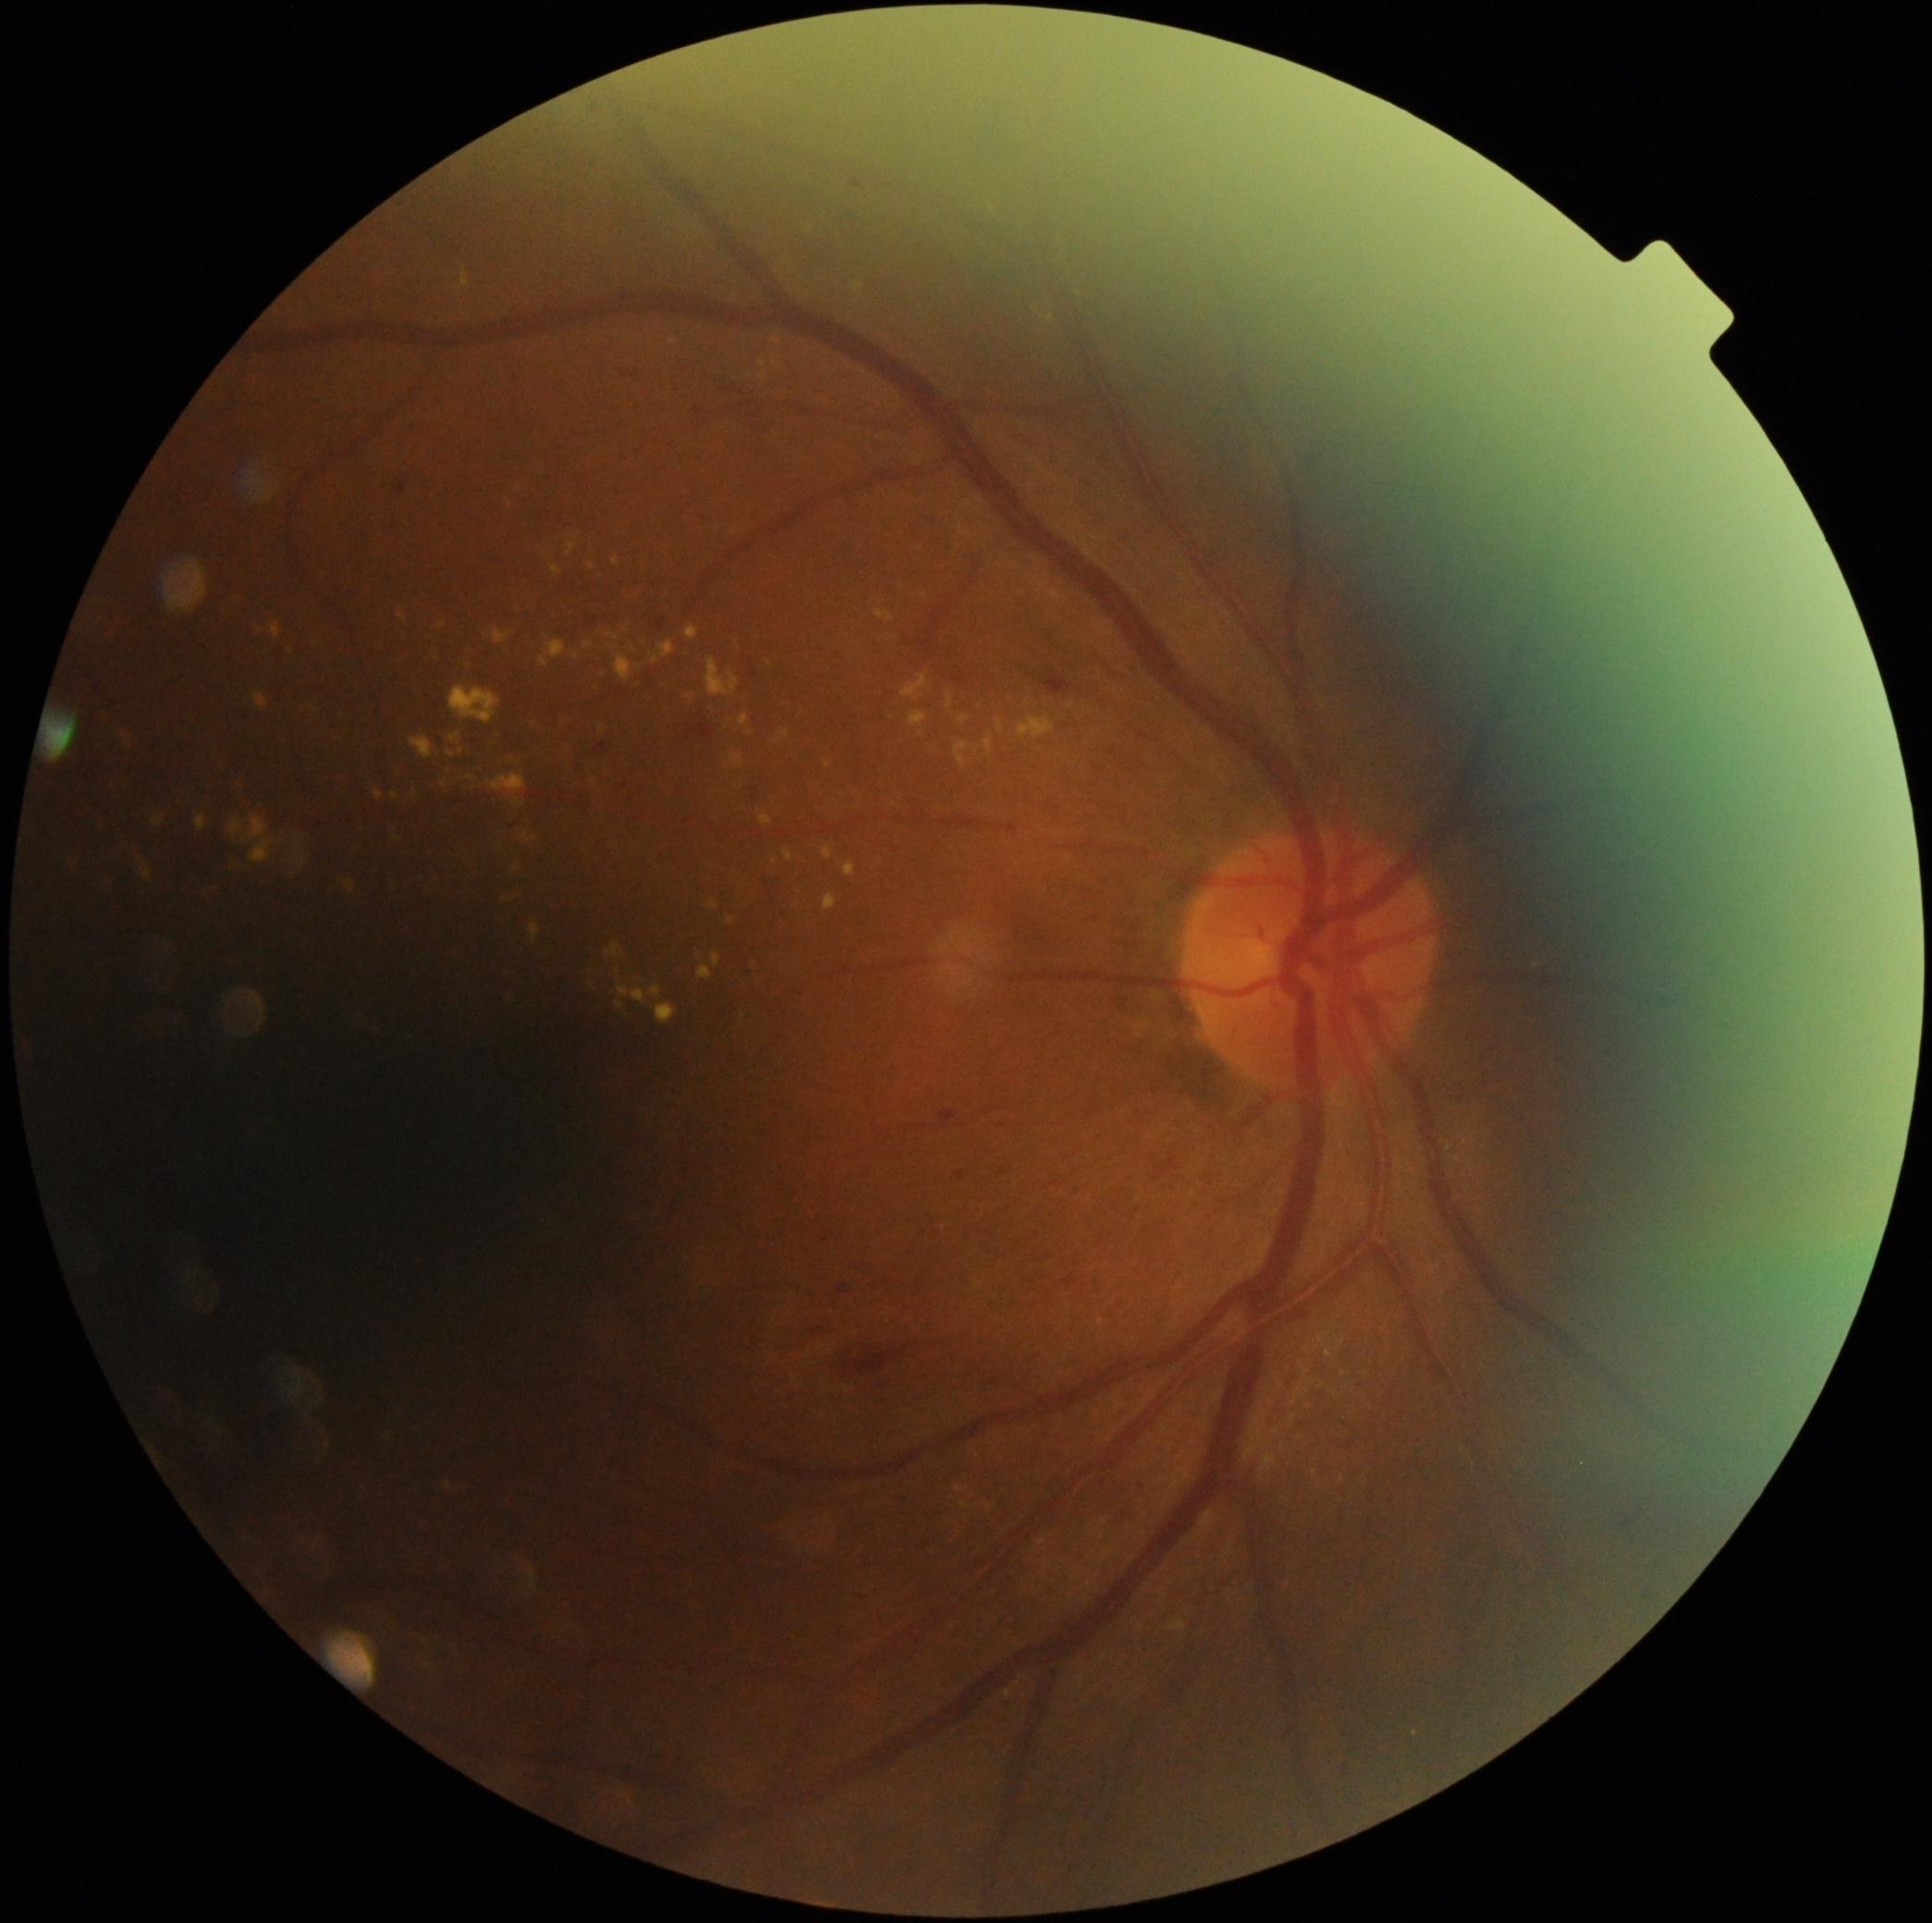

Diabetic retinopathy (DR): grade 2
Selected lesions:
hard exudates (EXs) (more not shown): <box>739,715,750,726</box> | <box>618,984,649,1004</box> | <box>698,964,713,980</box> | <box>468,664,473,673</box> | <box>608,634,619,642</box> | <box>442,768,449,777</box> | <box>131,851,141,865</box> | <box>997,722,1006,735</box> | <box>875,610,894,621</box> | <box>438,623,447,631</box> | <box>705,658,739,698</box> | <box>956,742,969,766</box> | <box>956,1486,969,1493</box> | <box>984,737,993,755</box>
Small EXs approximately at x=596, y=781 | x=535, y=724 | x=291, y=652 | x=775, y=861 | x=423, y=879 | x=461, y=751